CFP · 2048x1536
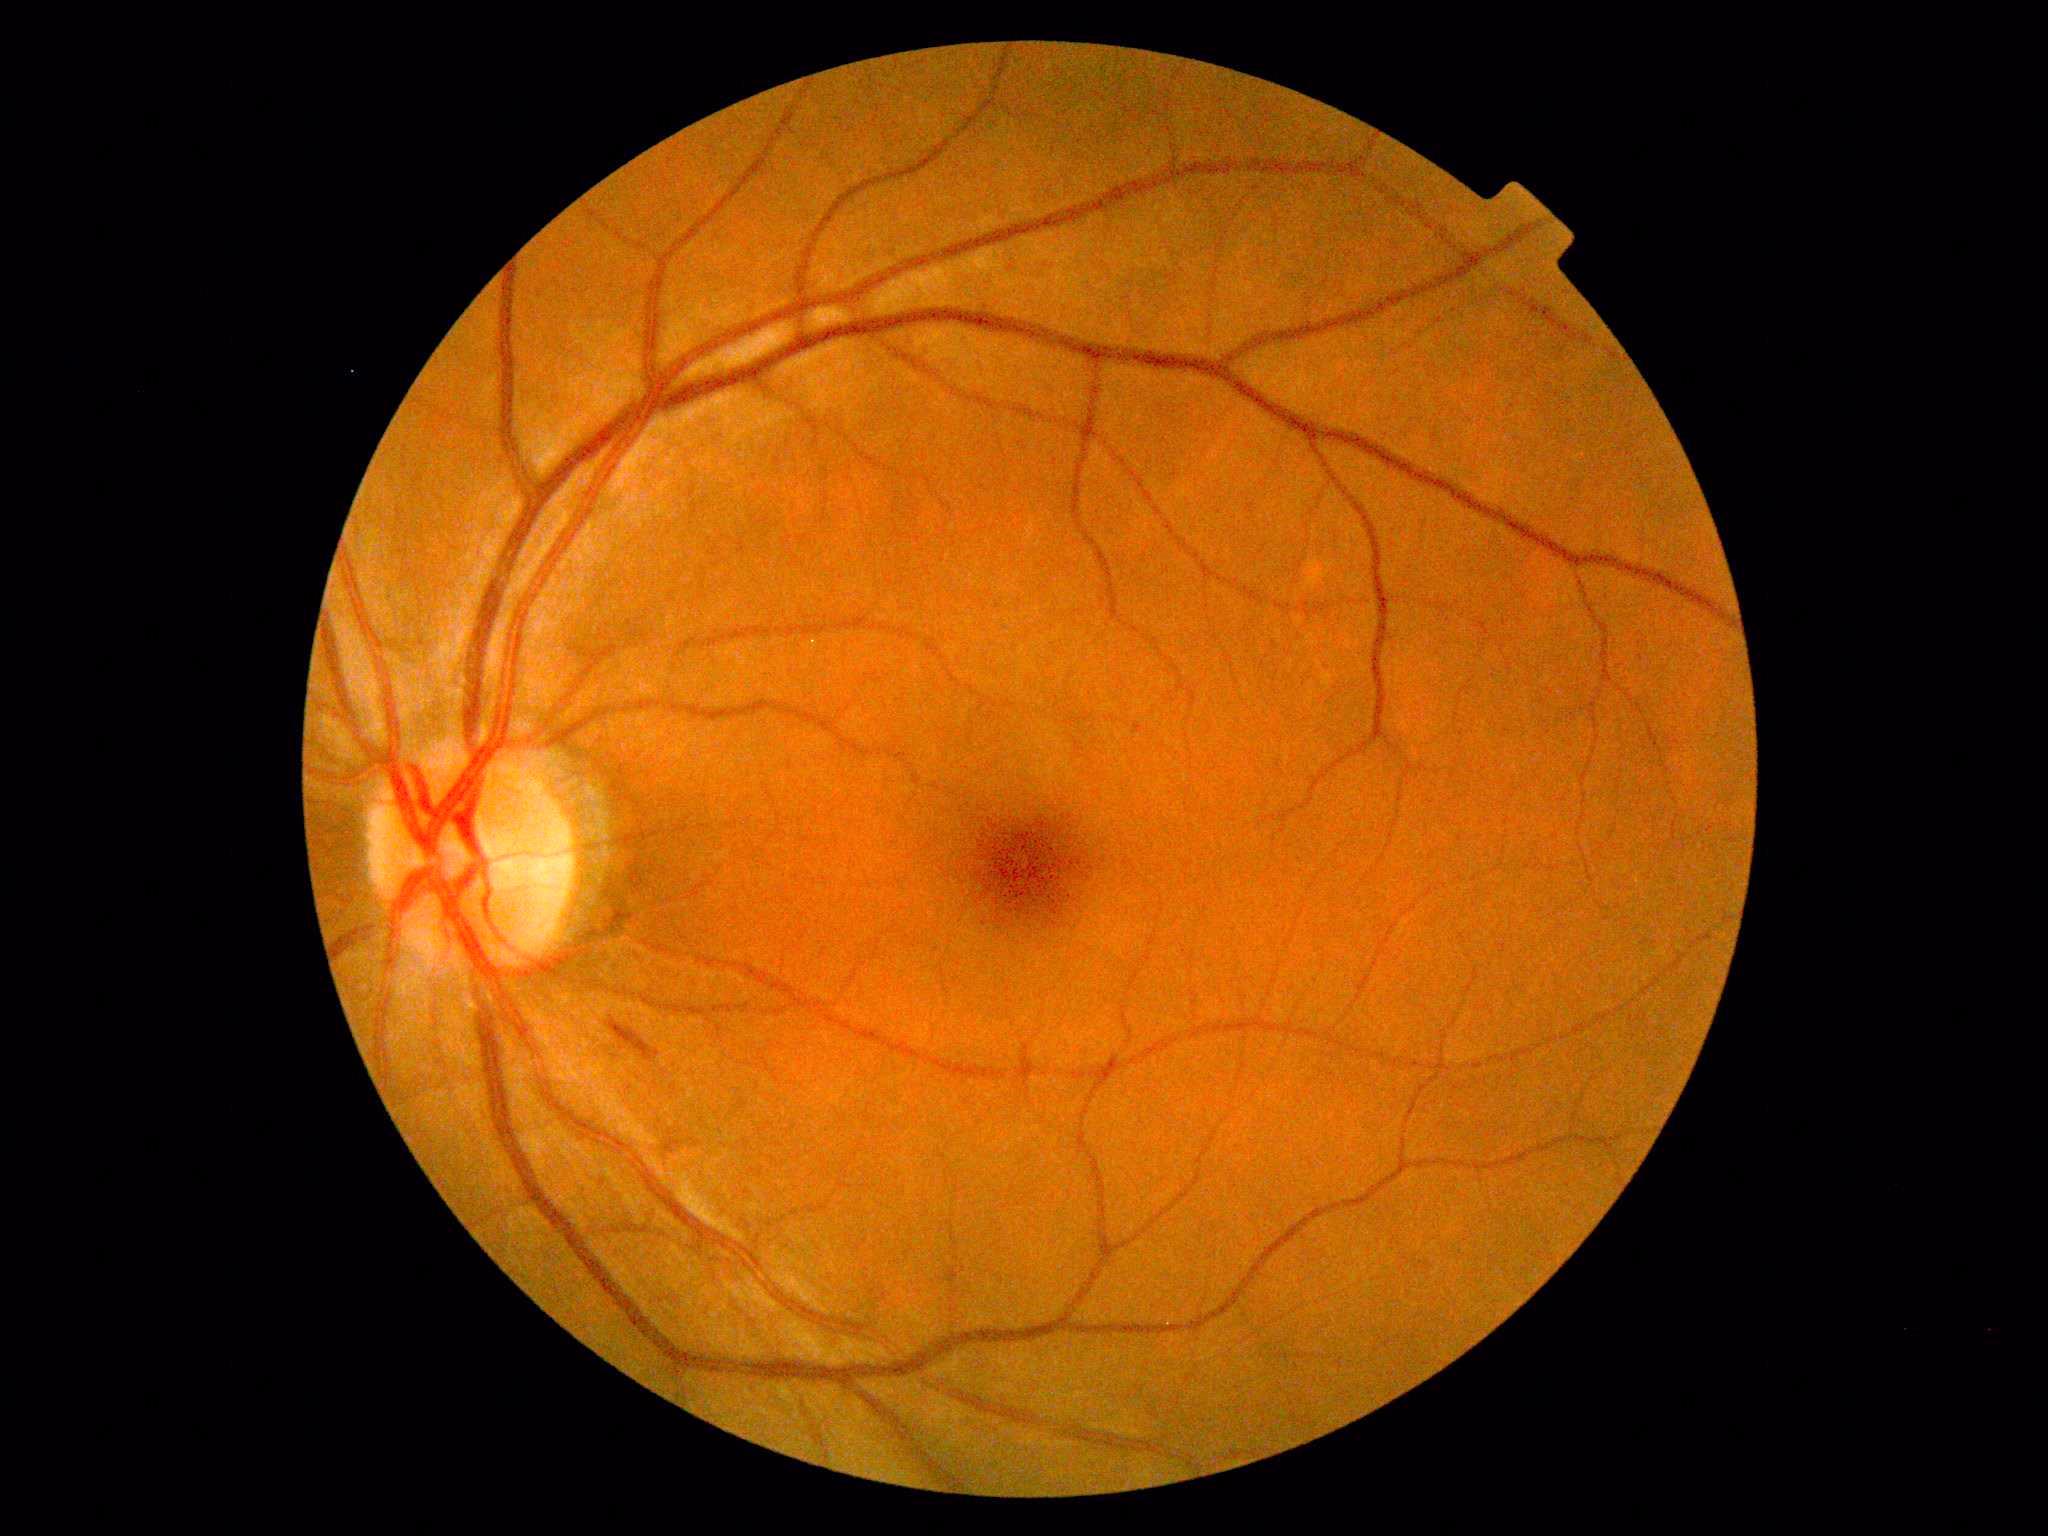 Diabetic retinopathy (DR) is moderate NPDR (grade 2). DR class: non-proliferative diabetic retinopathy.